Ultra-widefield (UWF) fundus image
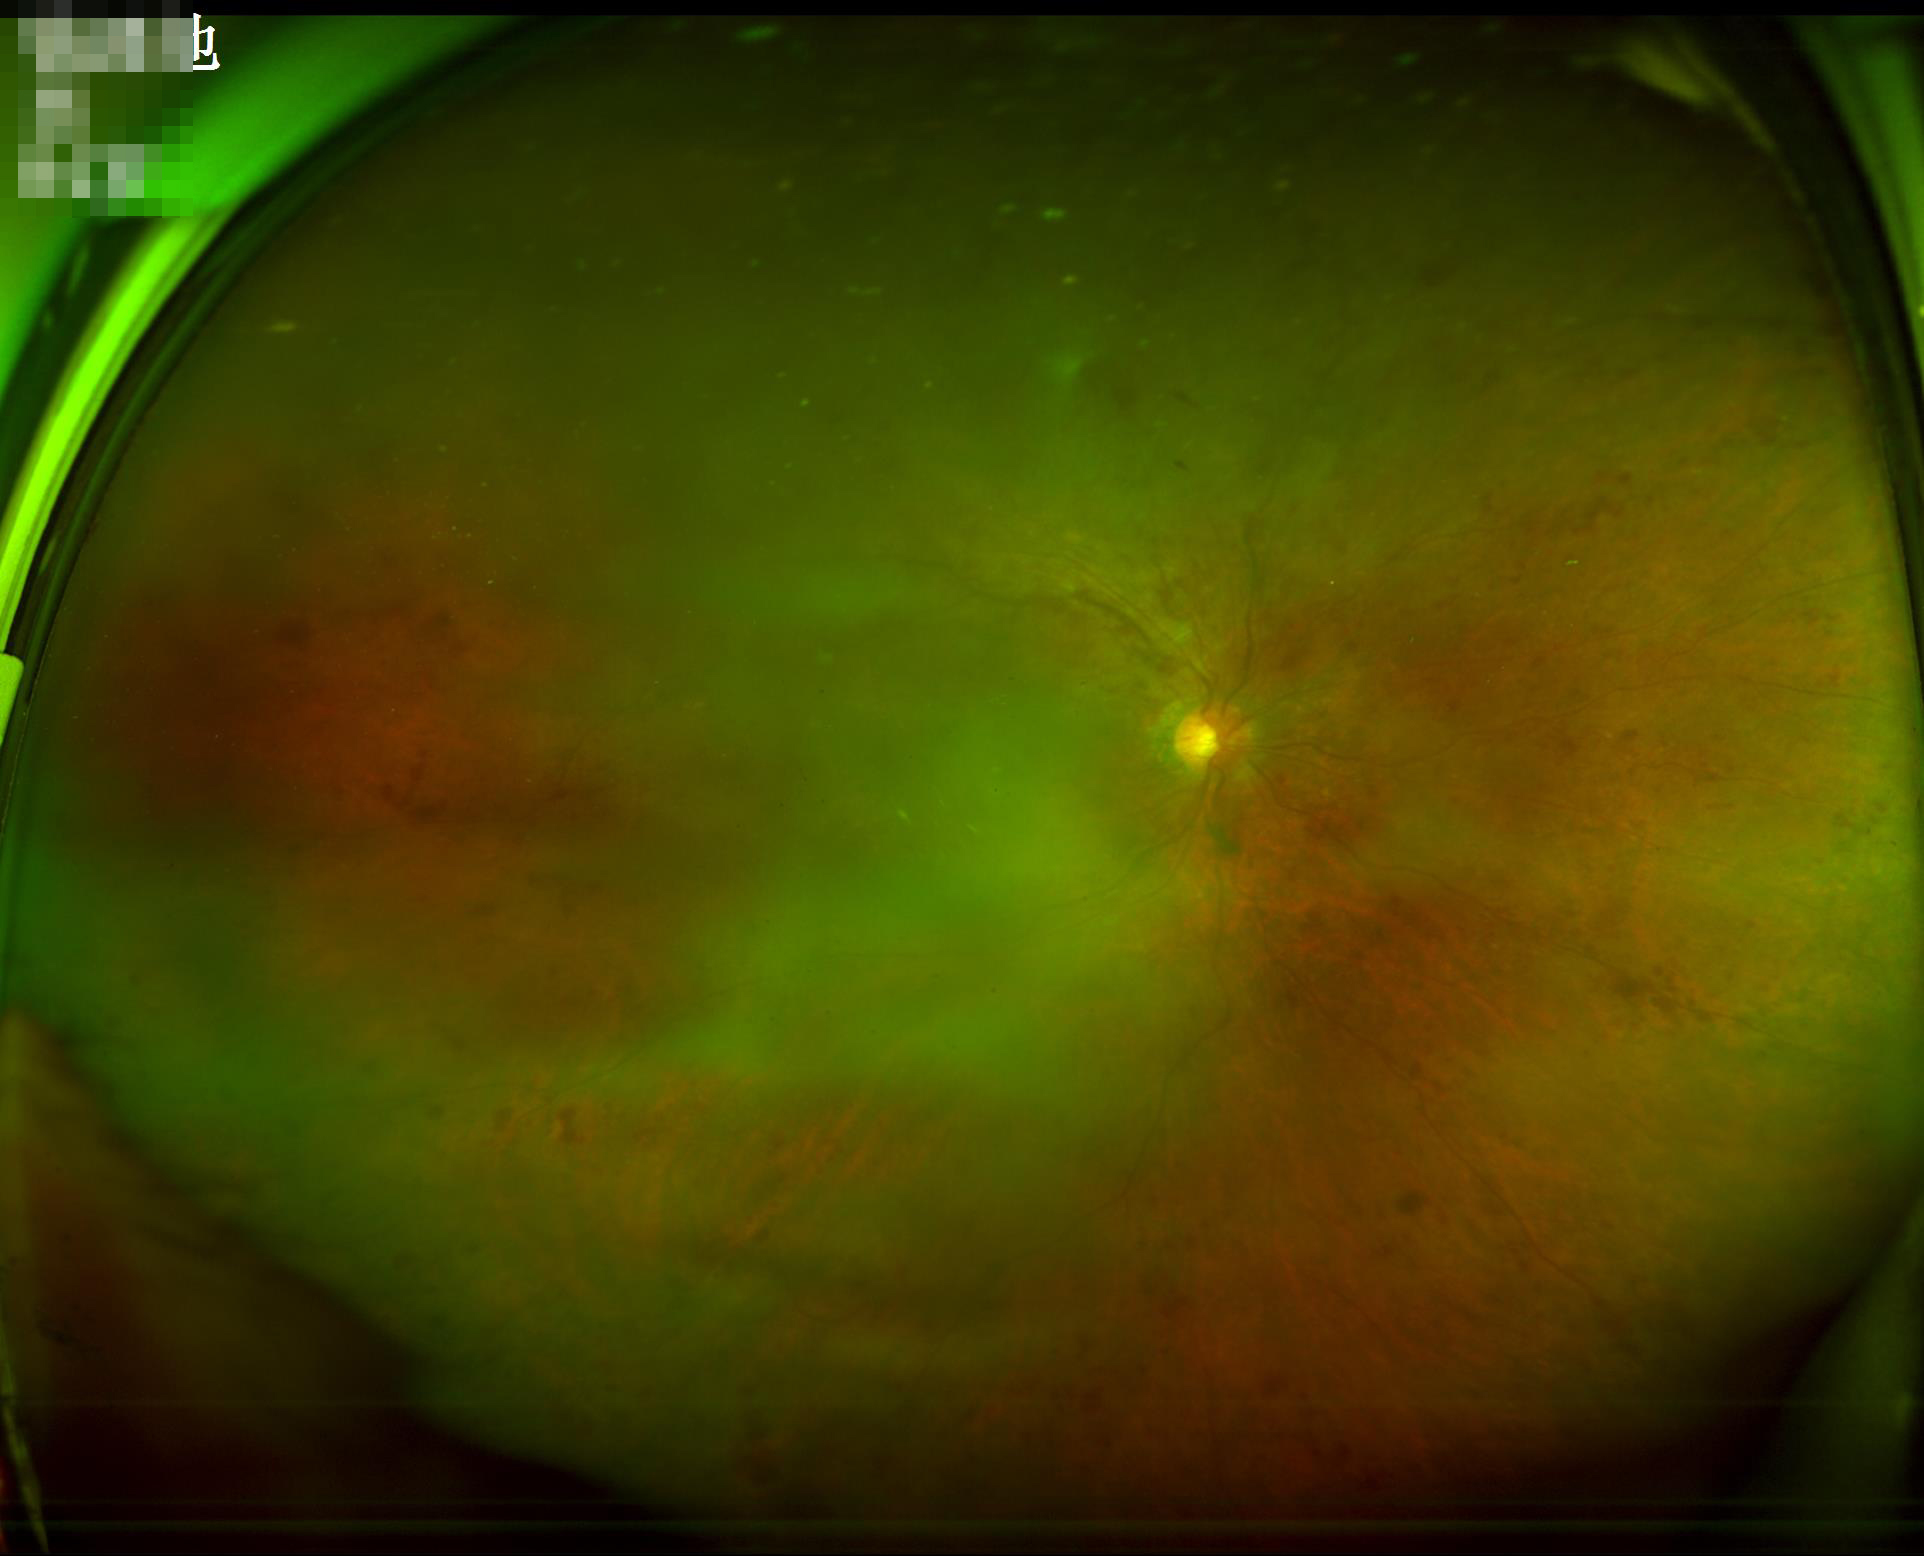 Noticeable blur in the optic disc, vessels, or background.
Image quality is suboptimal.
There is over- or under-exposure or a color cast.
Contrast is low.